Posterior pole photograph.
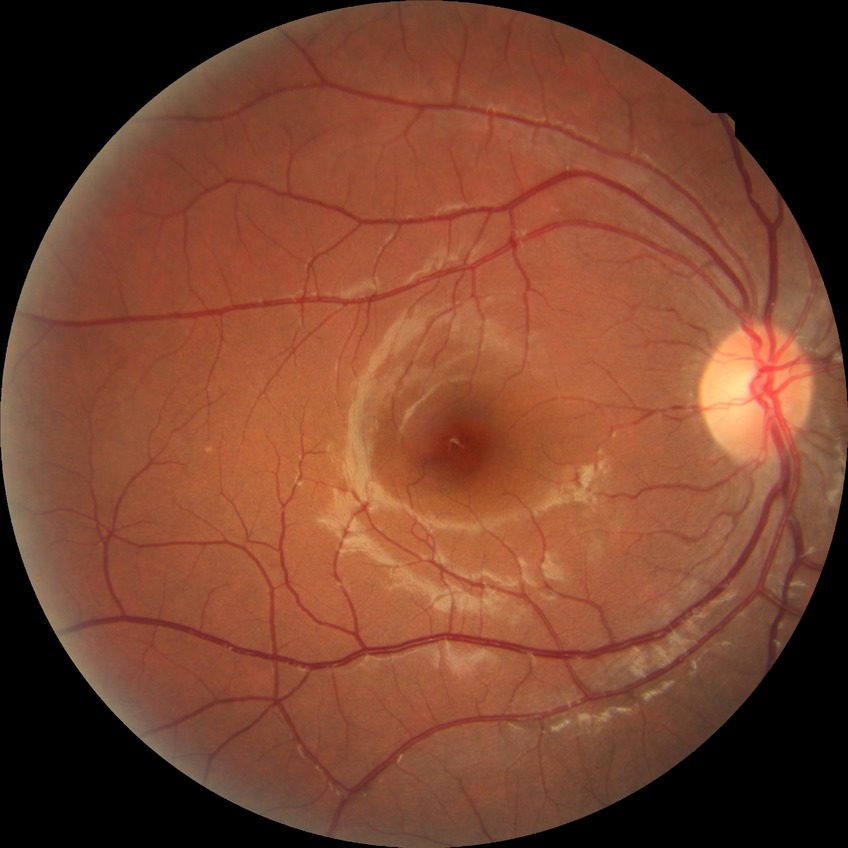

Modified Davis classification is no diabetic retinopathy.